Without pupil dilation. NIDEK AFC-230: 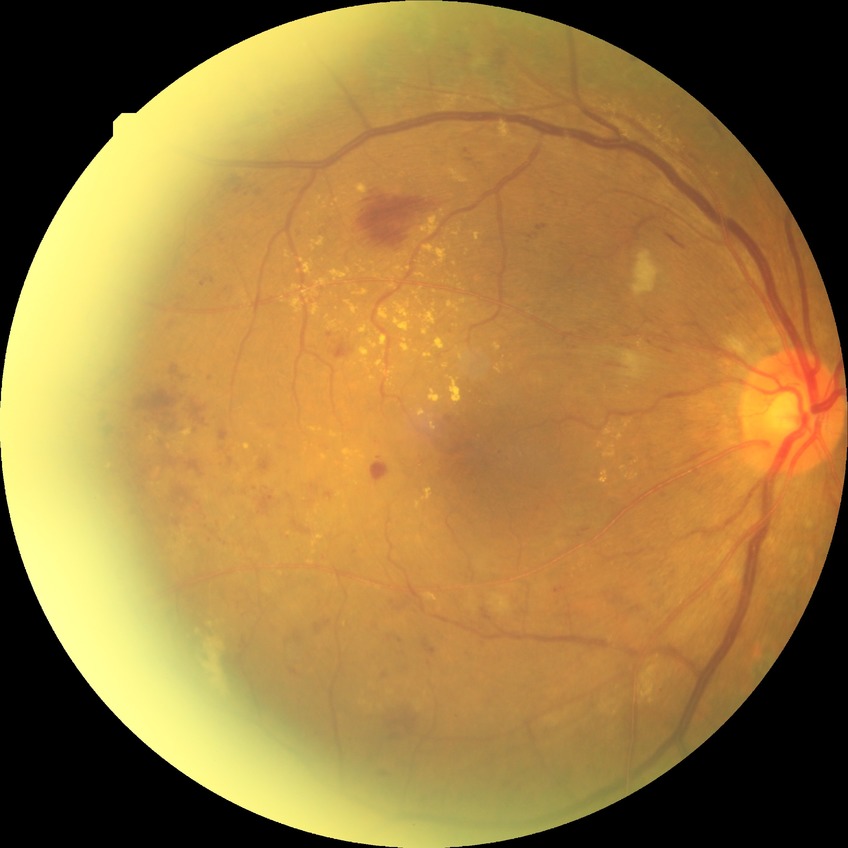

Diabetic retinopathy (DR): proliferative diabetic retinopathy (PDR).